Color fundus image.
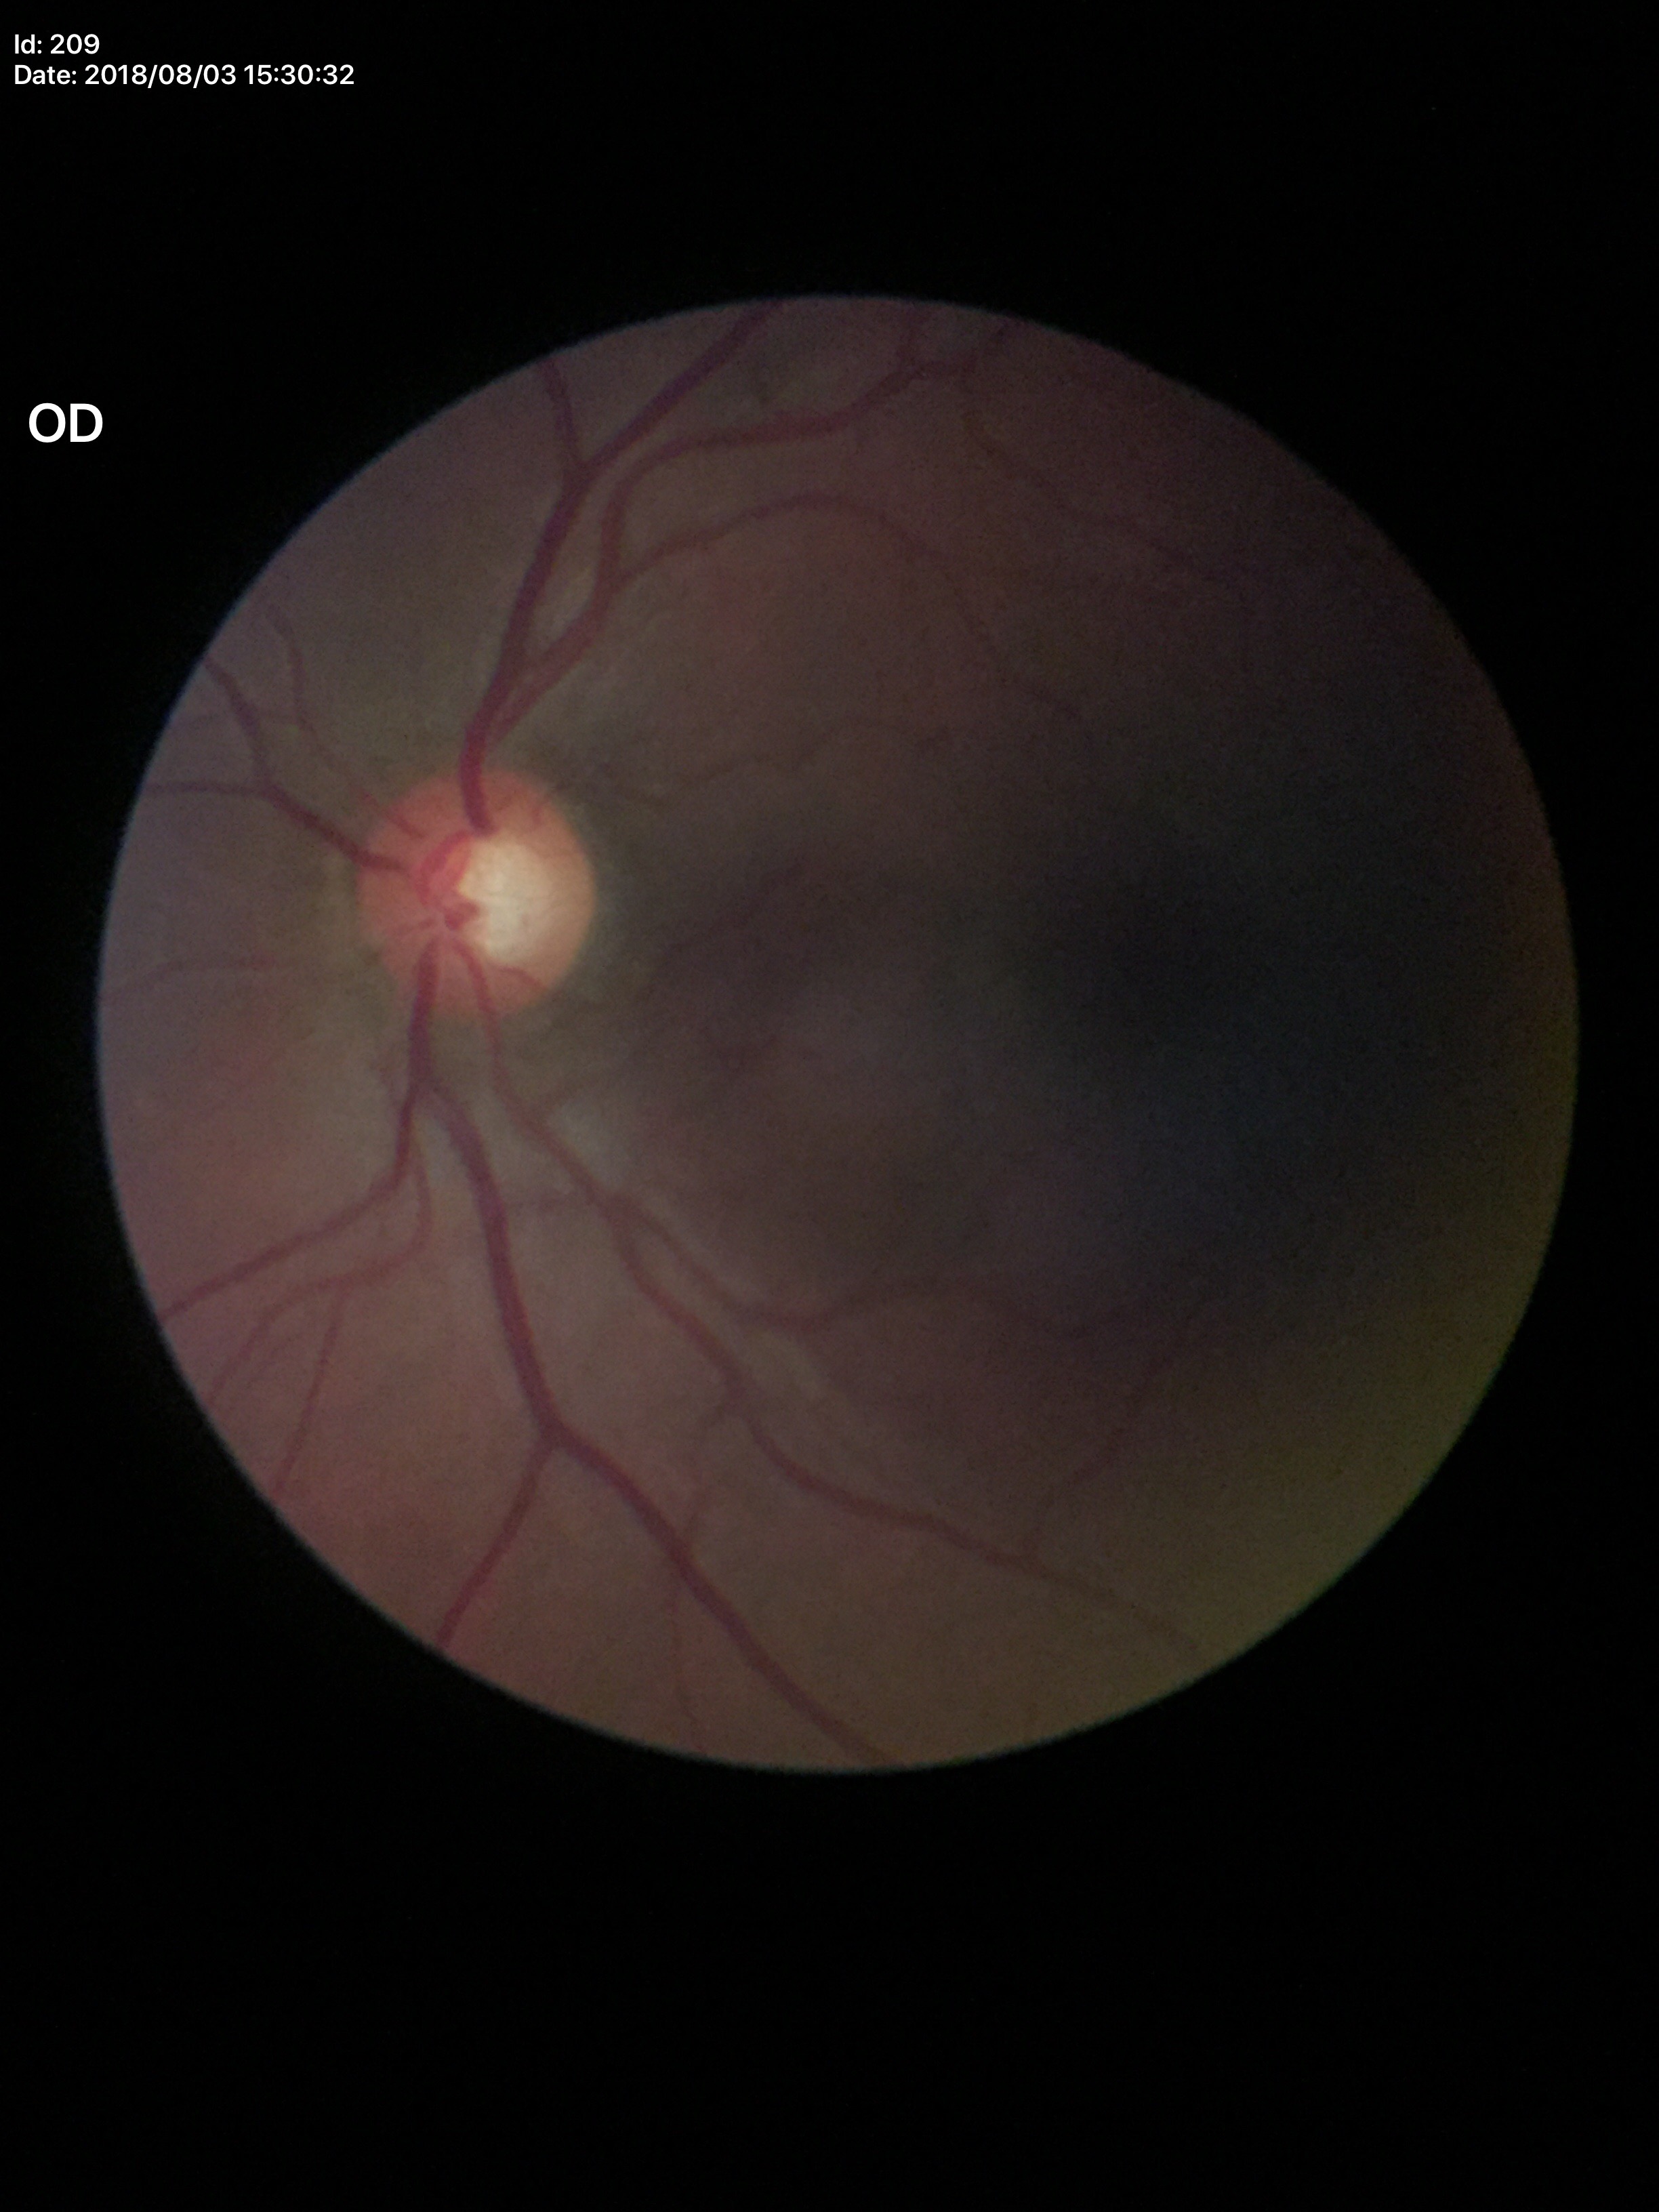

Q: Vertical CDR?
A: 0.59
Q: What is the glaucoma assessment?
A: negative
Q: What is the area cup-to-disc ratio?
A: 0.35
Q: What is the HCDR?
A: 0.59